Portable fundus camera image. 60° FOV
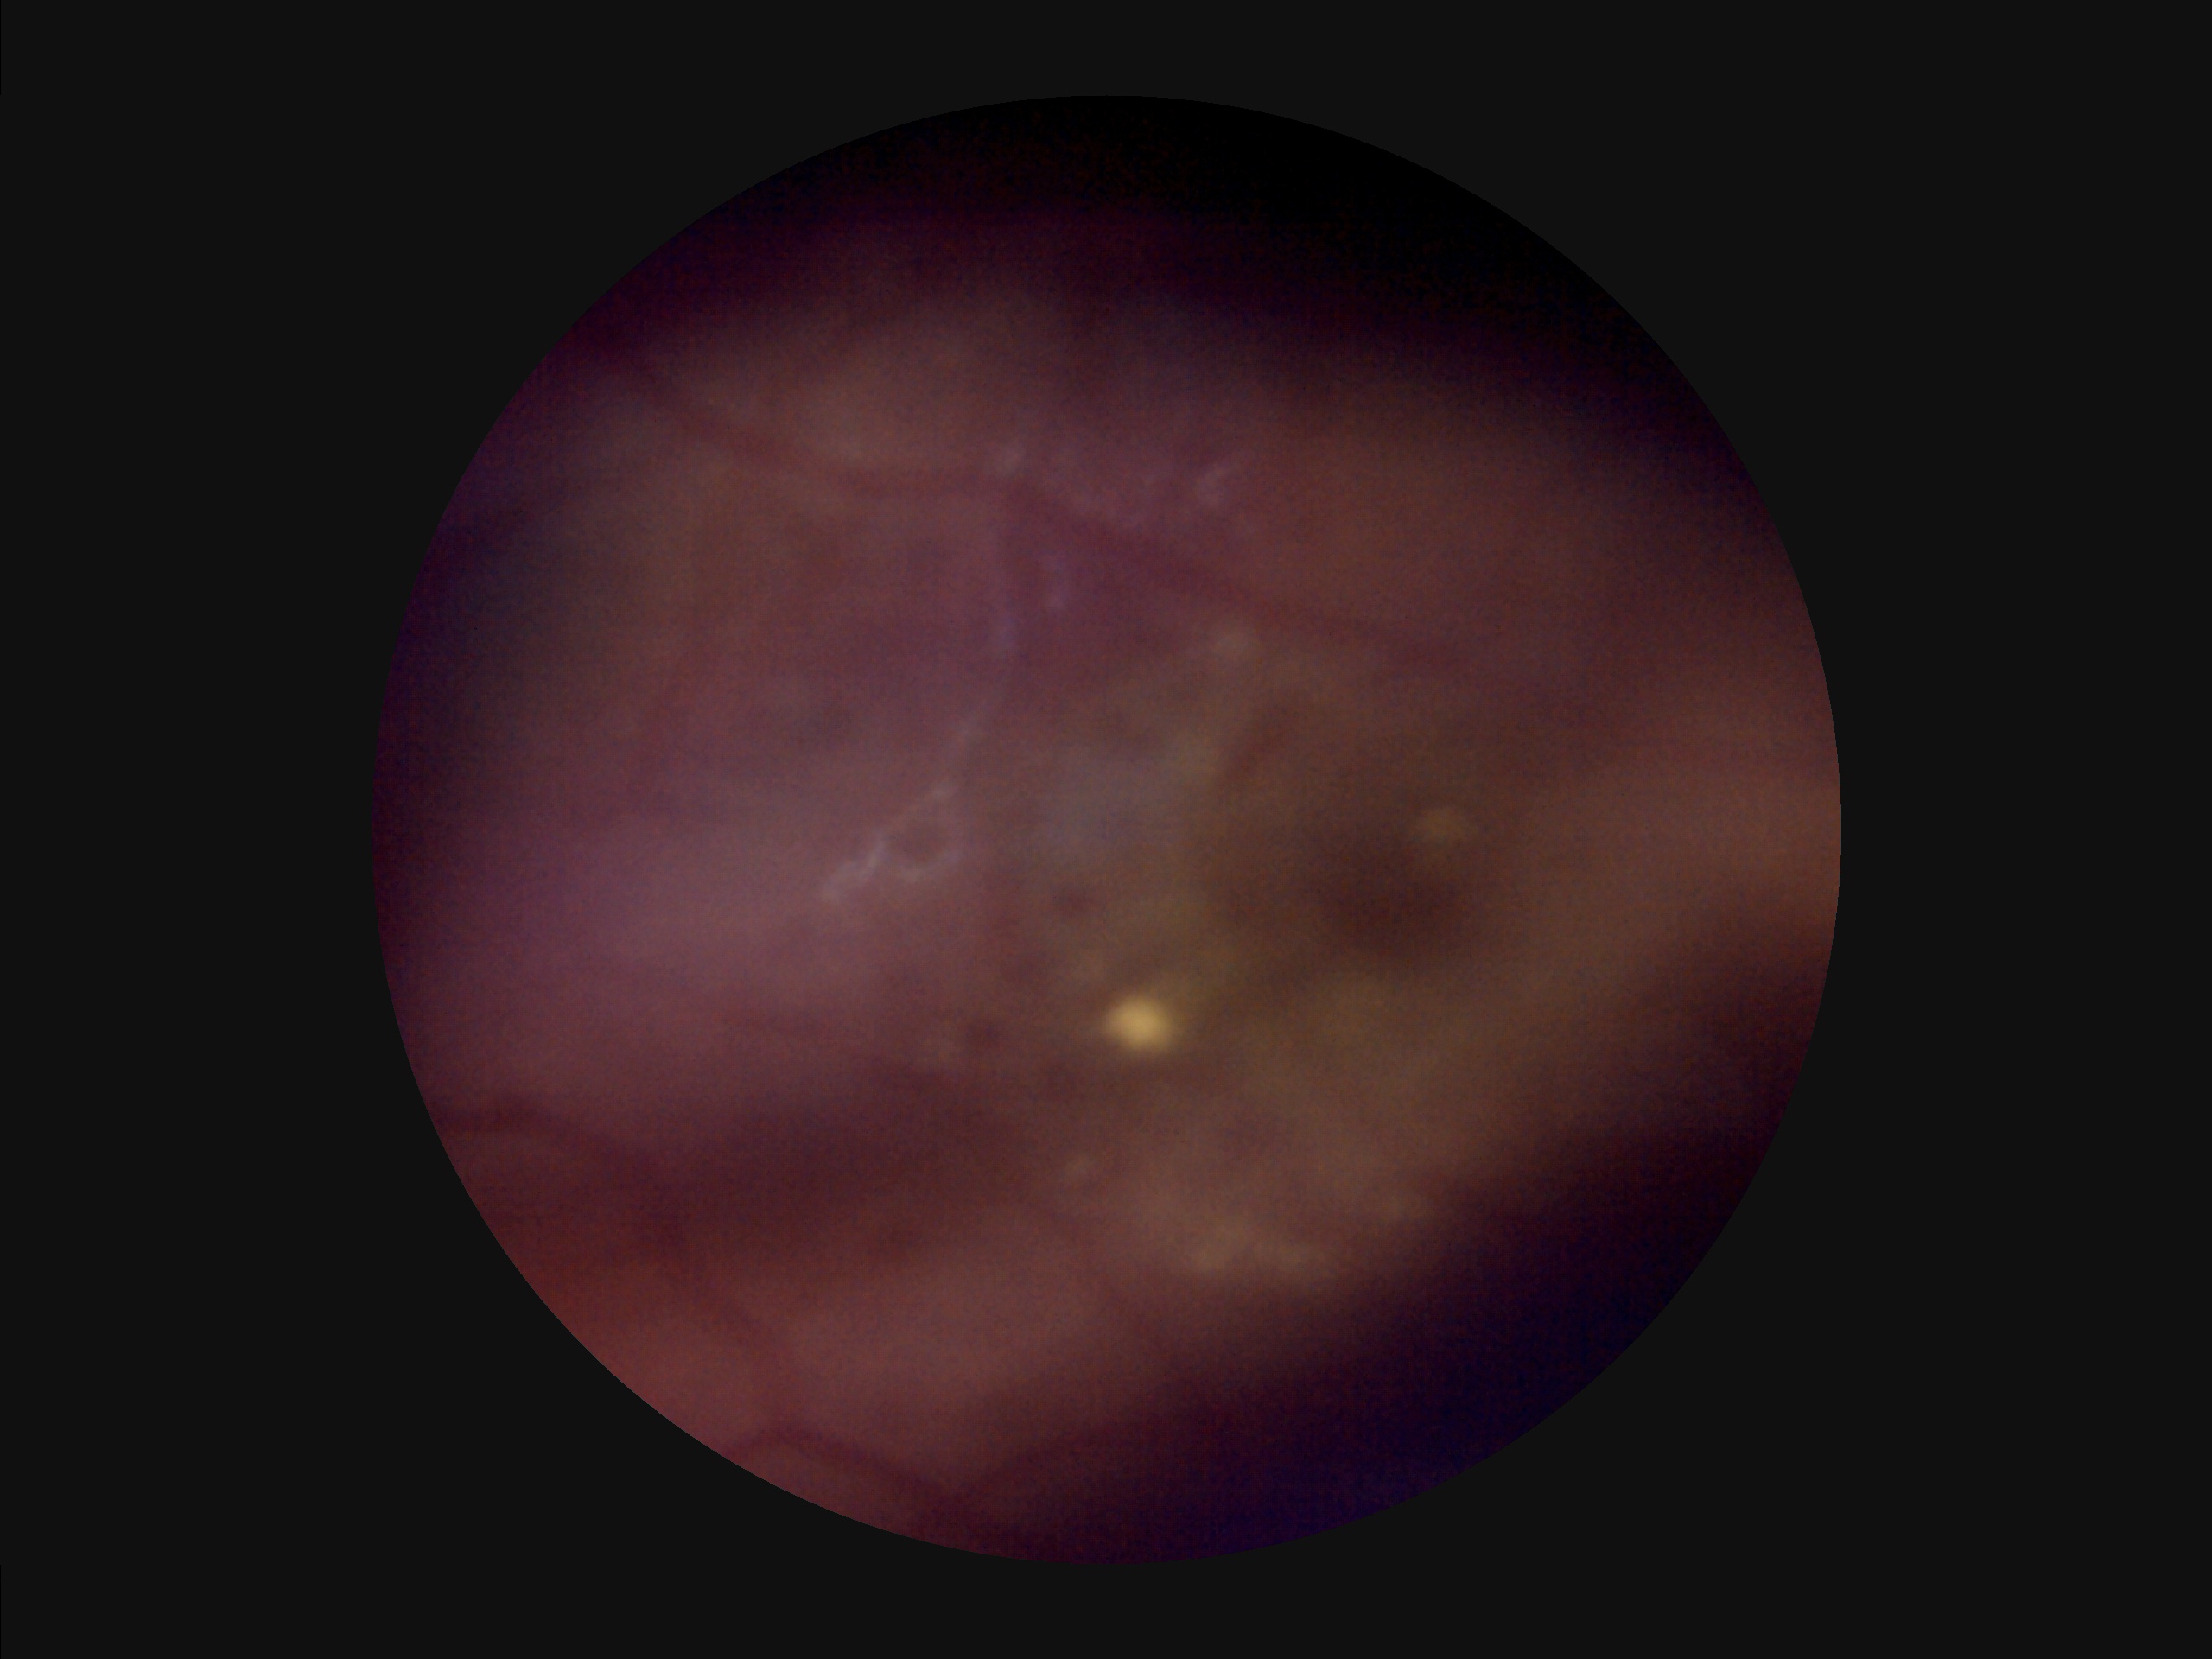
{
  "overall_quality": "suboptimal",
  "contrast": "reduced",
  "clarity": "out of focus",
  "illumination": "poor"
}